Color fundus photograph:
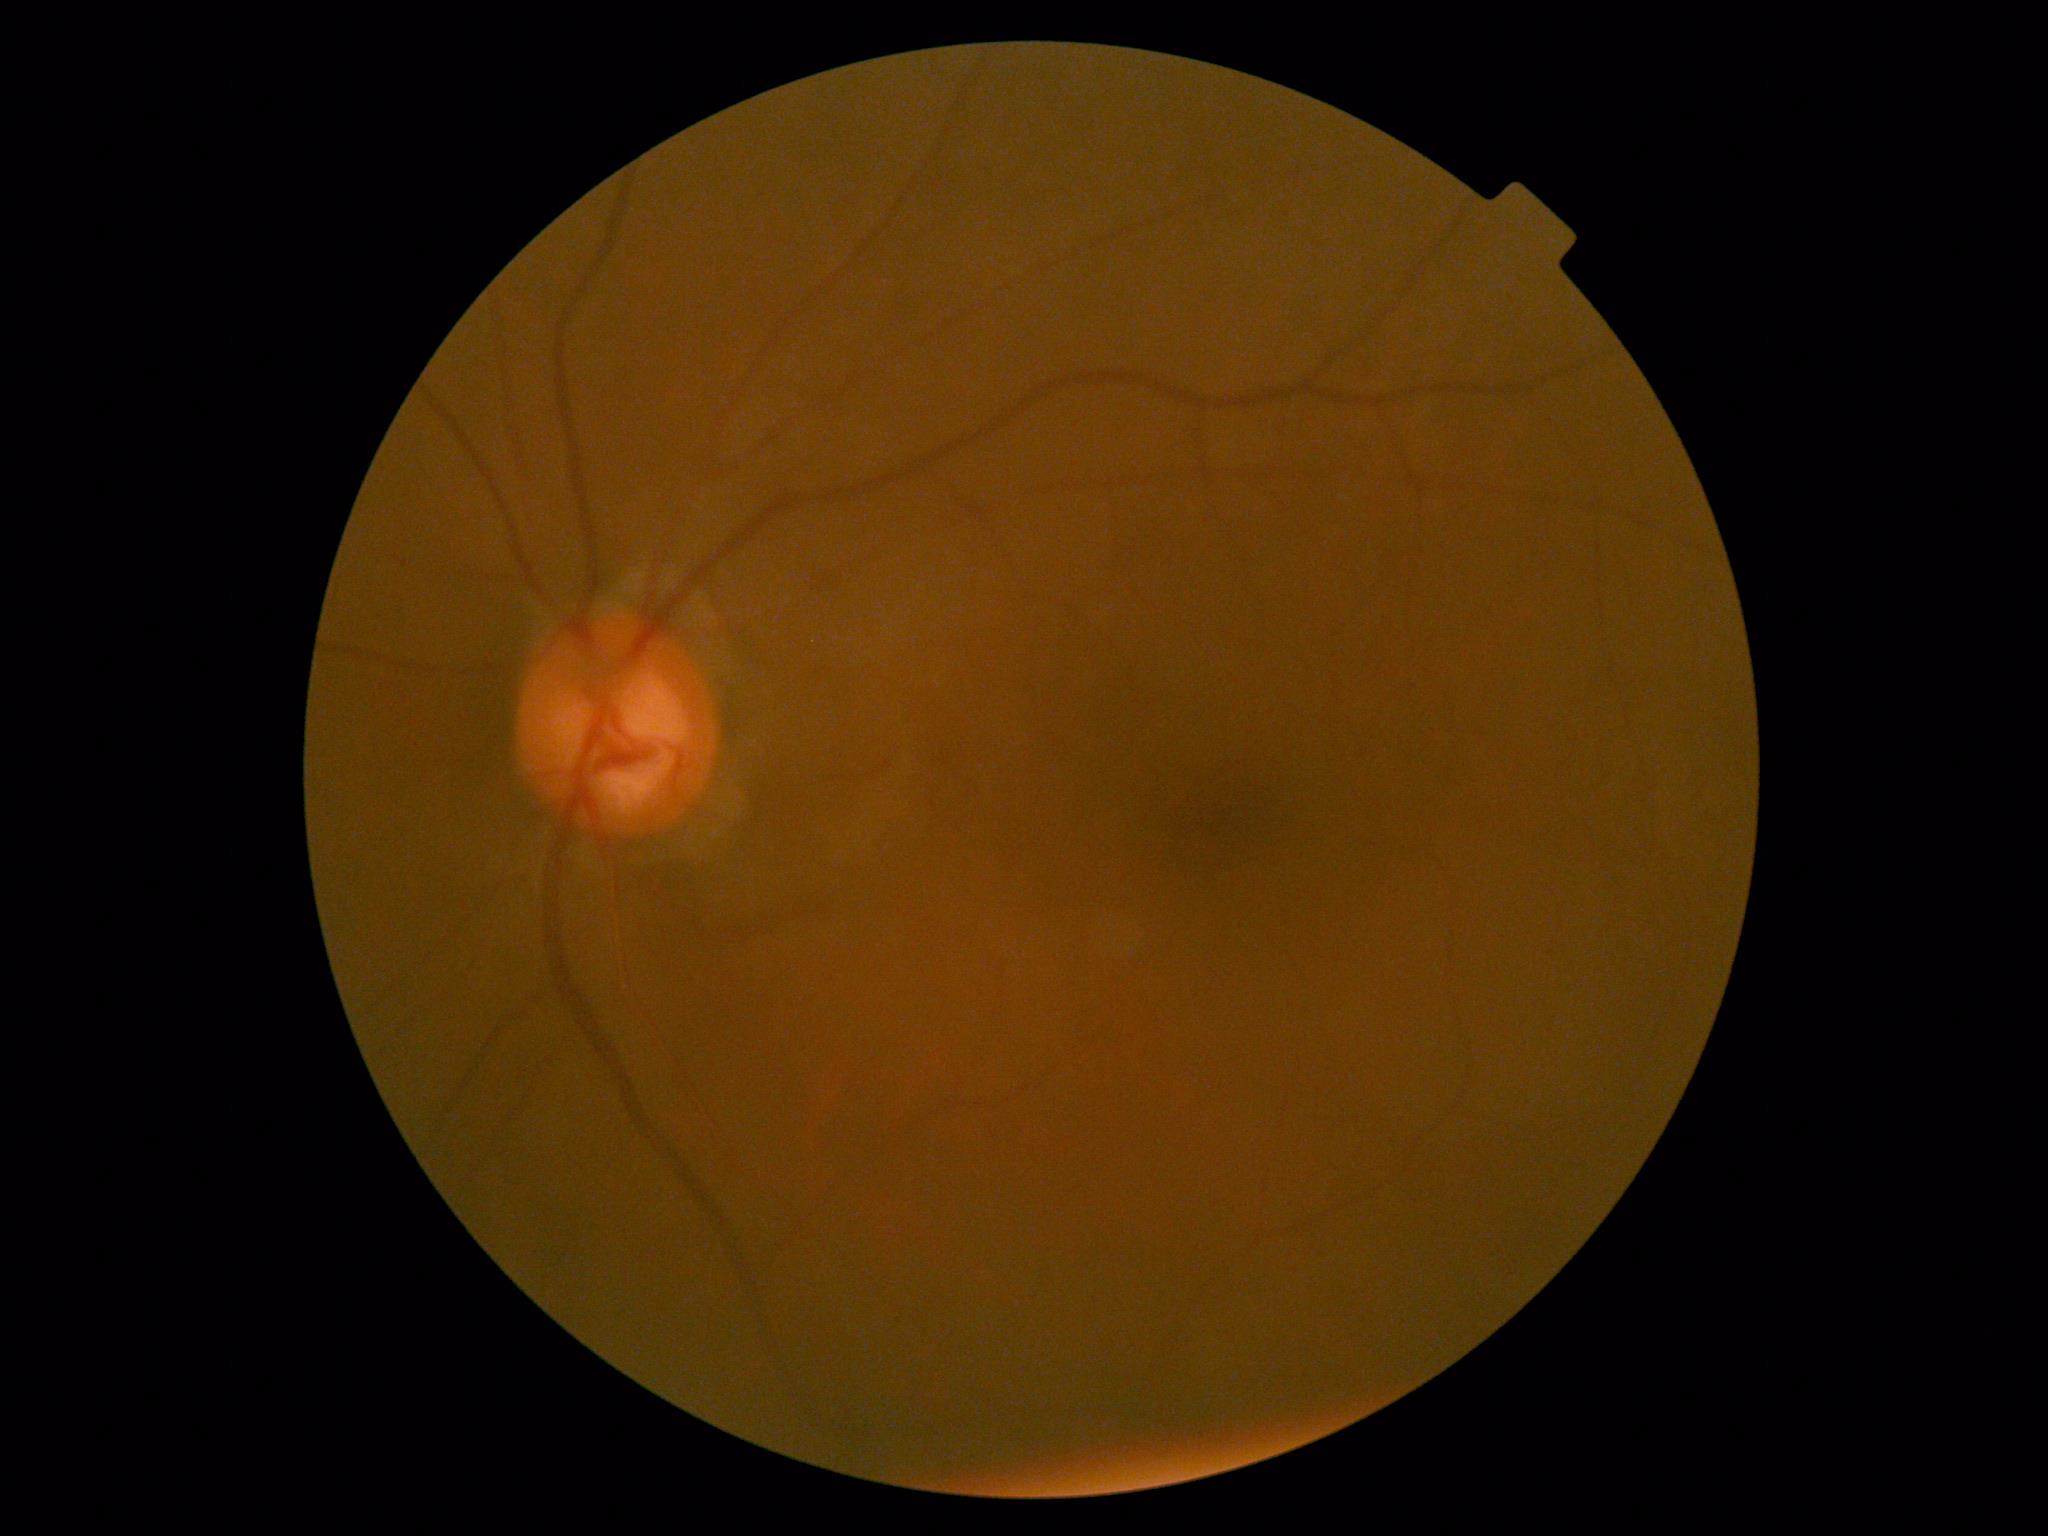

DR severity is 0/4.